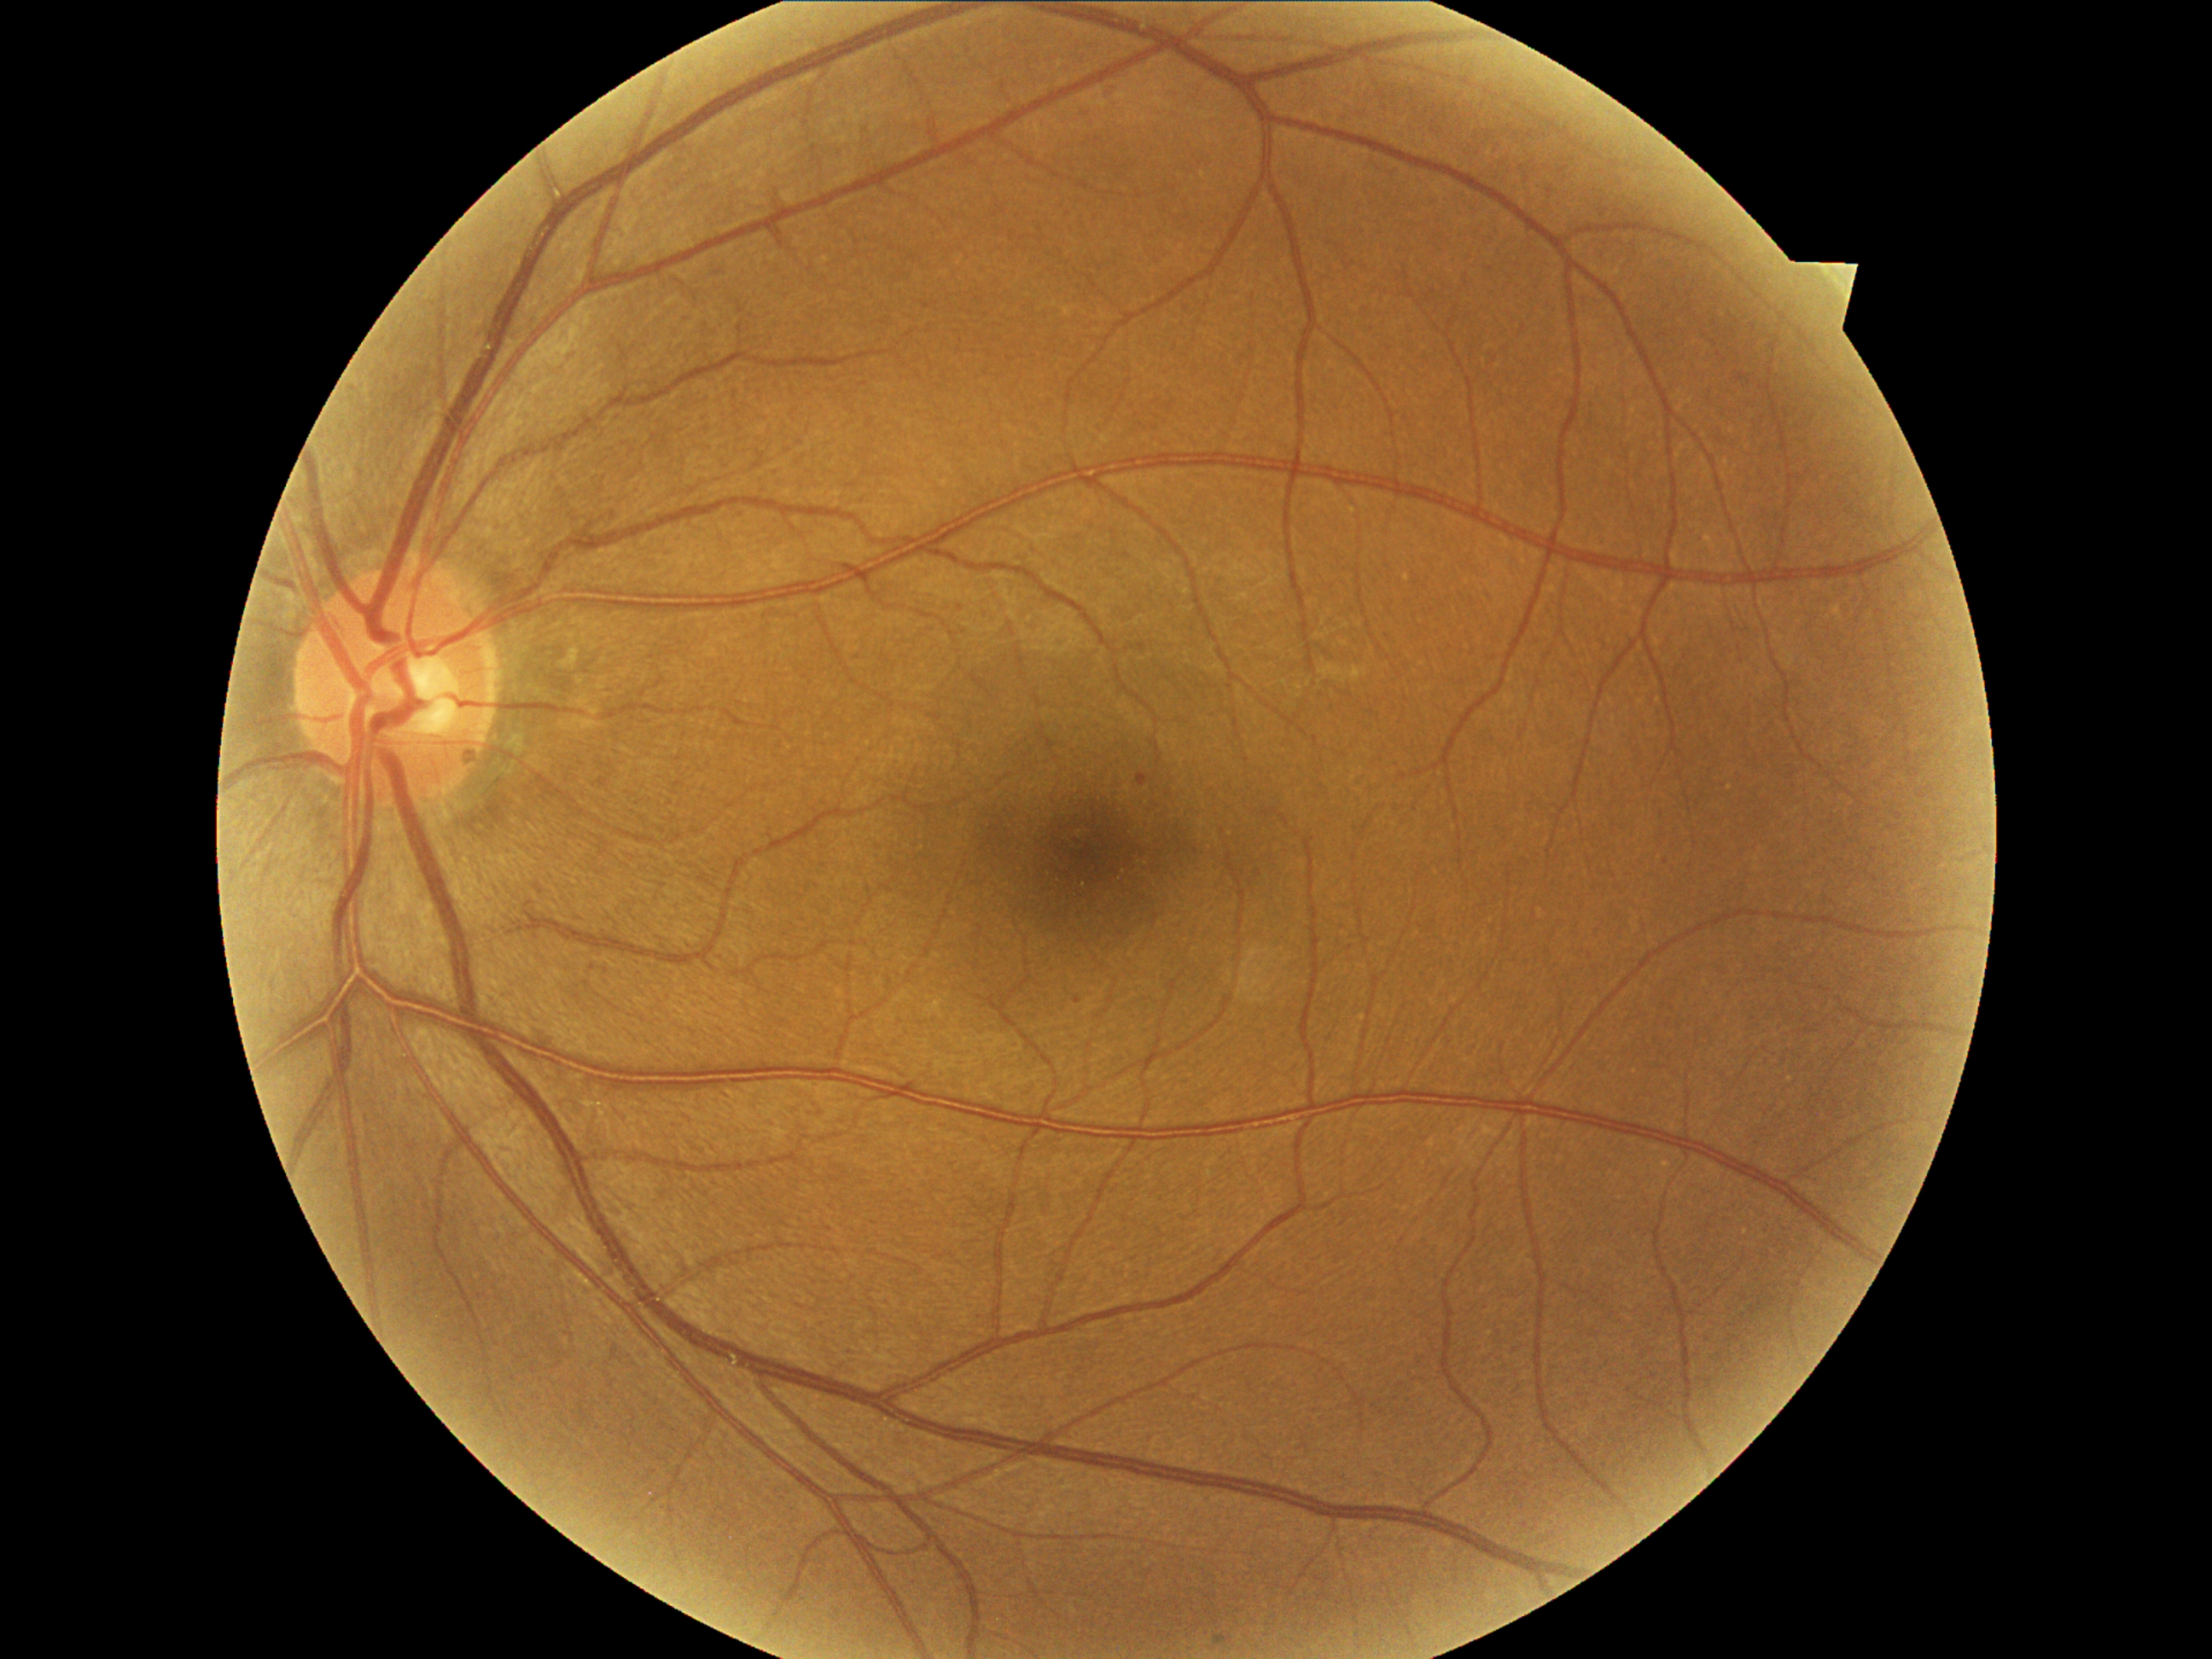
DR stage is grade 1
EXs: absent
HEs: absent
MAs: [left=1138, top=774, right=1148, bottom=788]
Small MAs approximately at Point(1077, 999)
SEs: absent